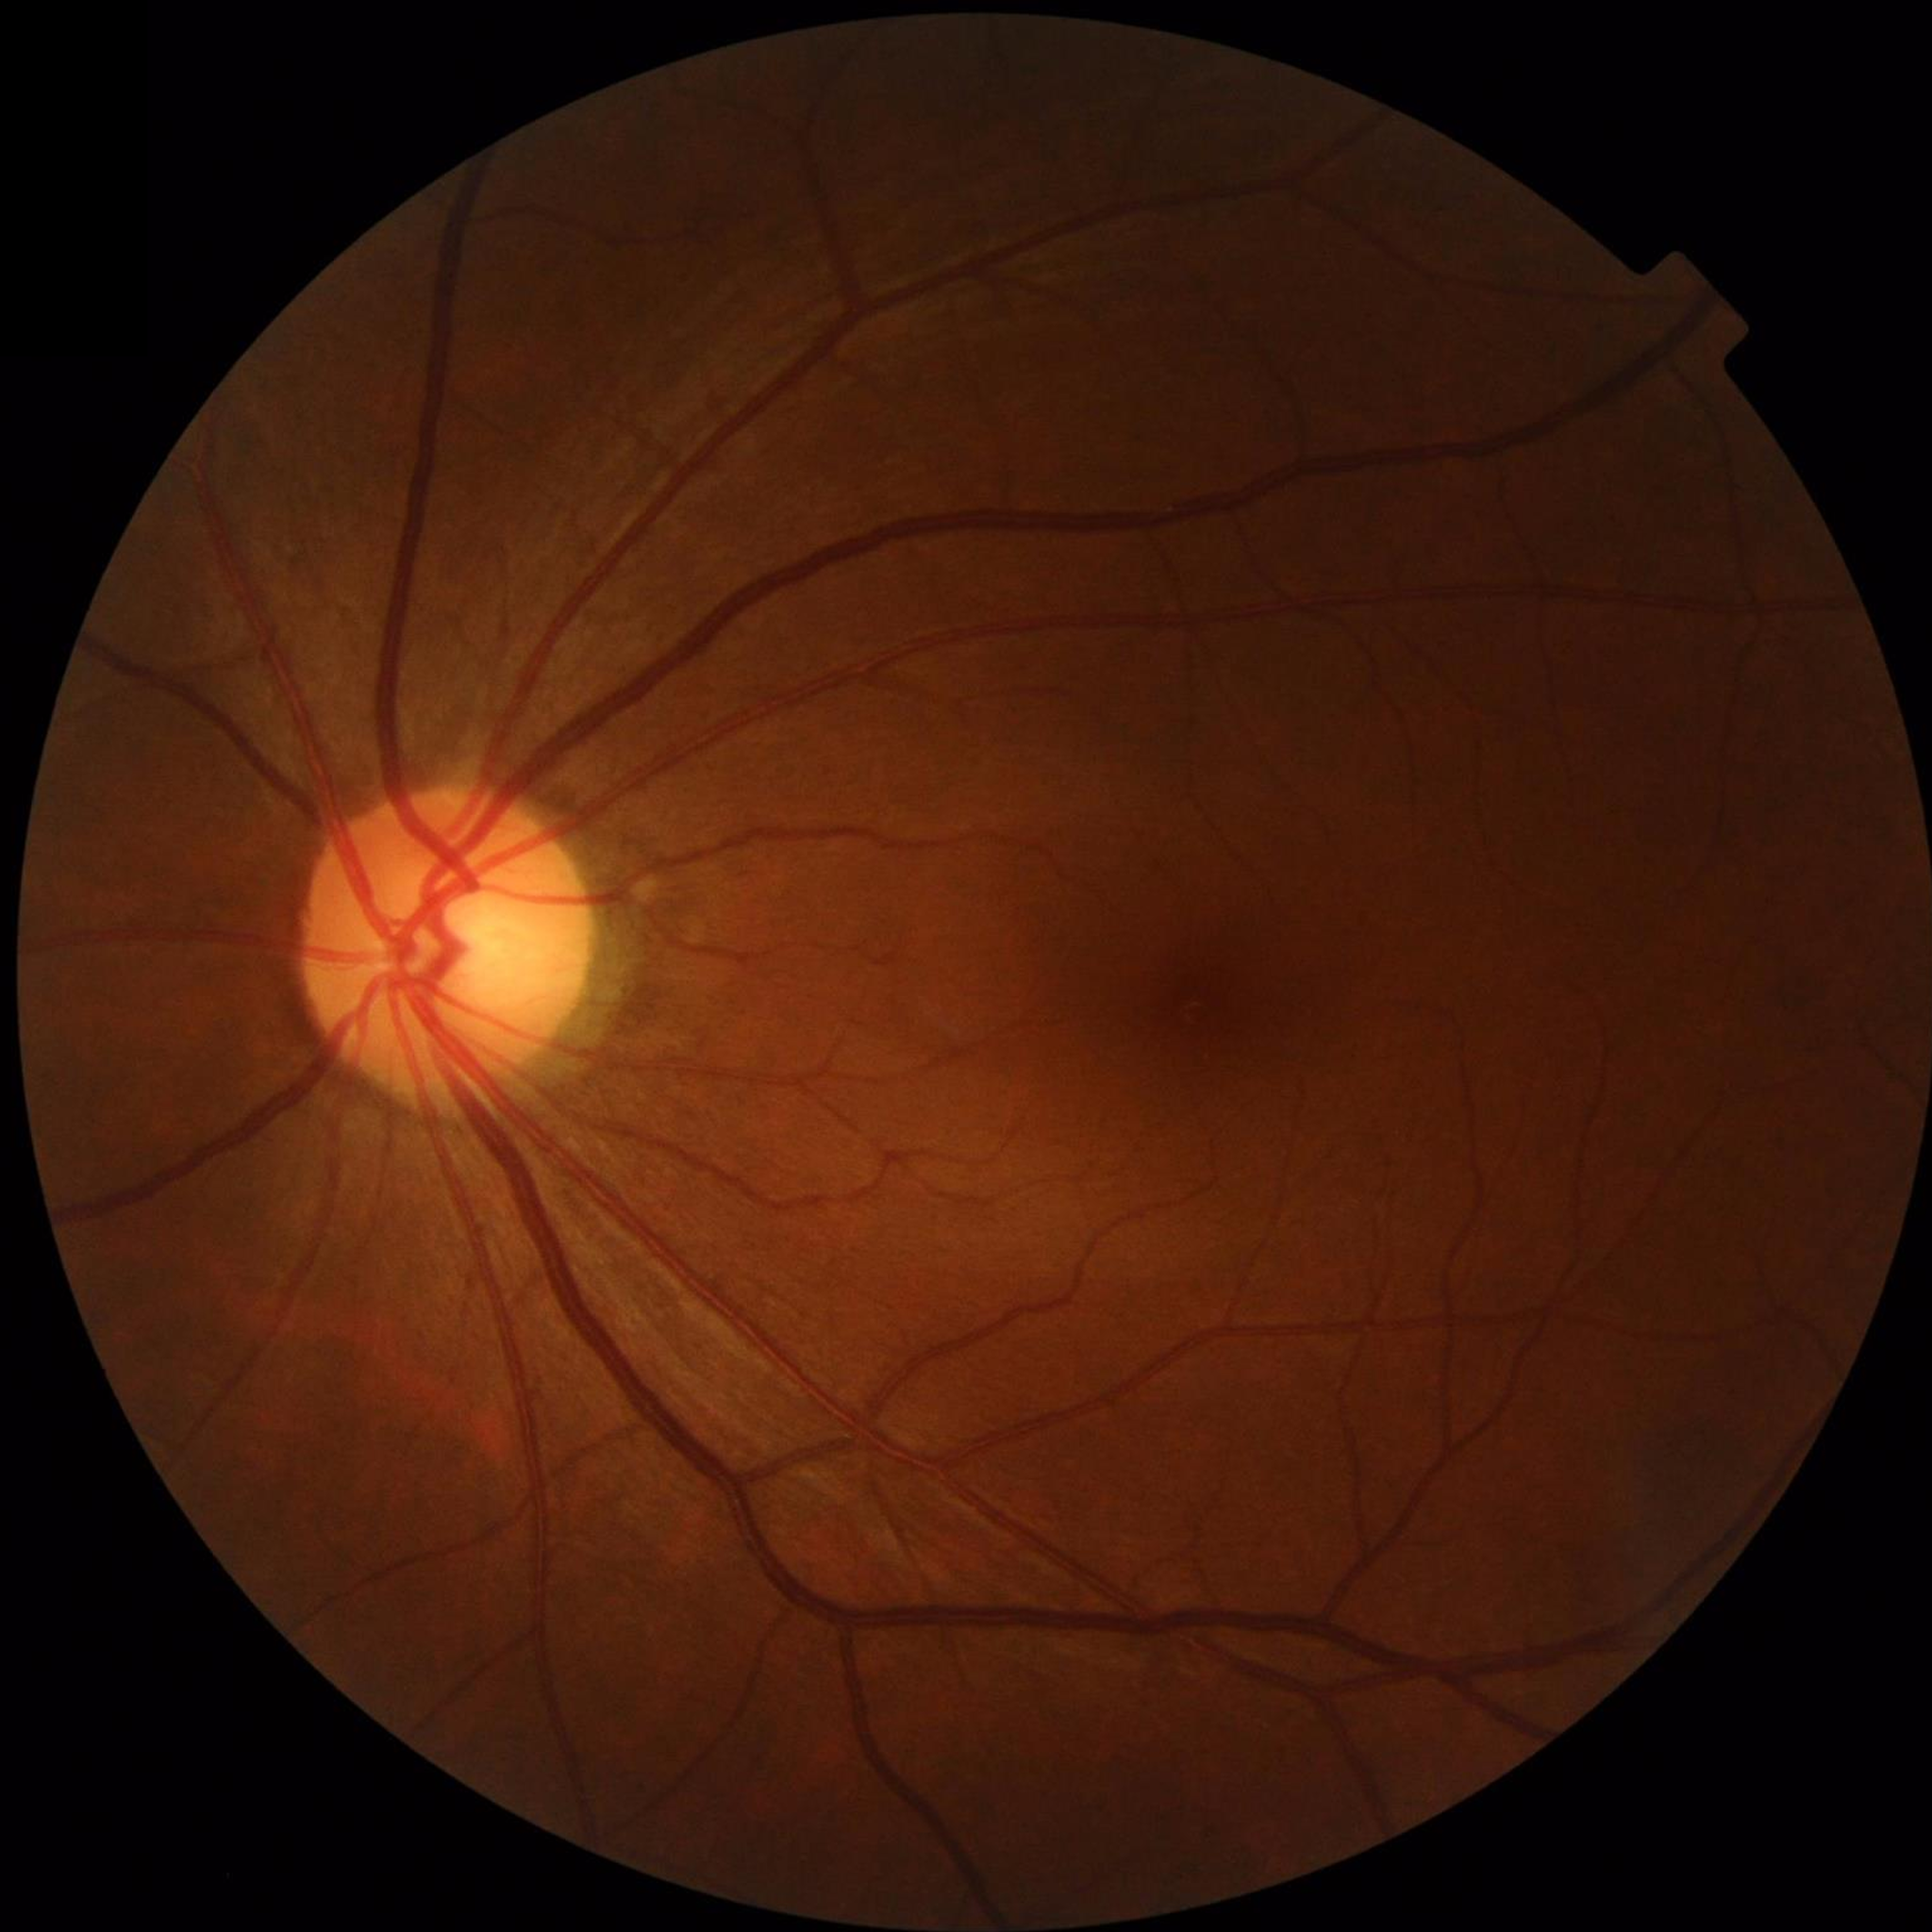

Color fundus photograph with no signs of AMD, diabetic retinopathy, or glaucoma.